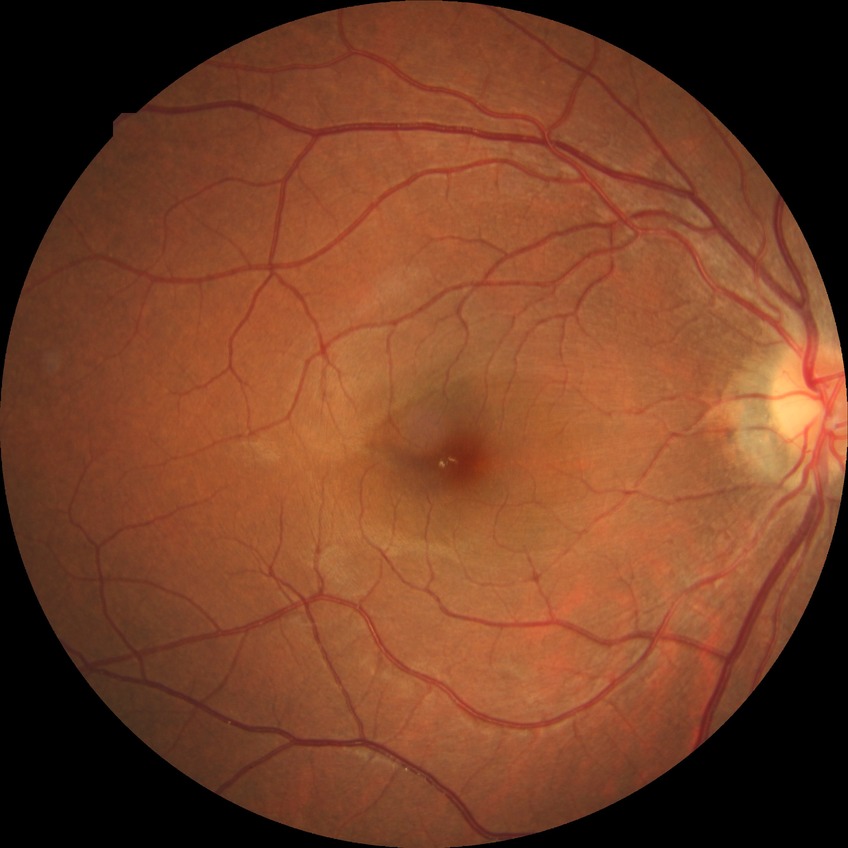

Annotations:
- diabetic retinopathy (DR): NDR (no diabetic retinopathy)